Pediatric wide-field fundus photograph.
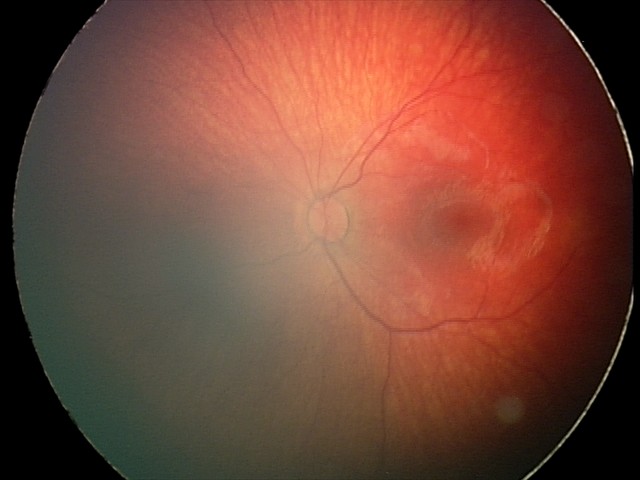
Diagnosis from this screening exam: retinal hemorrhages.